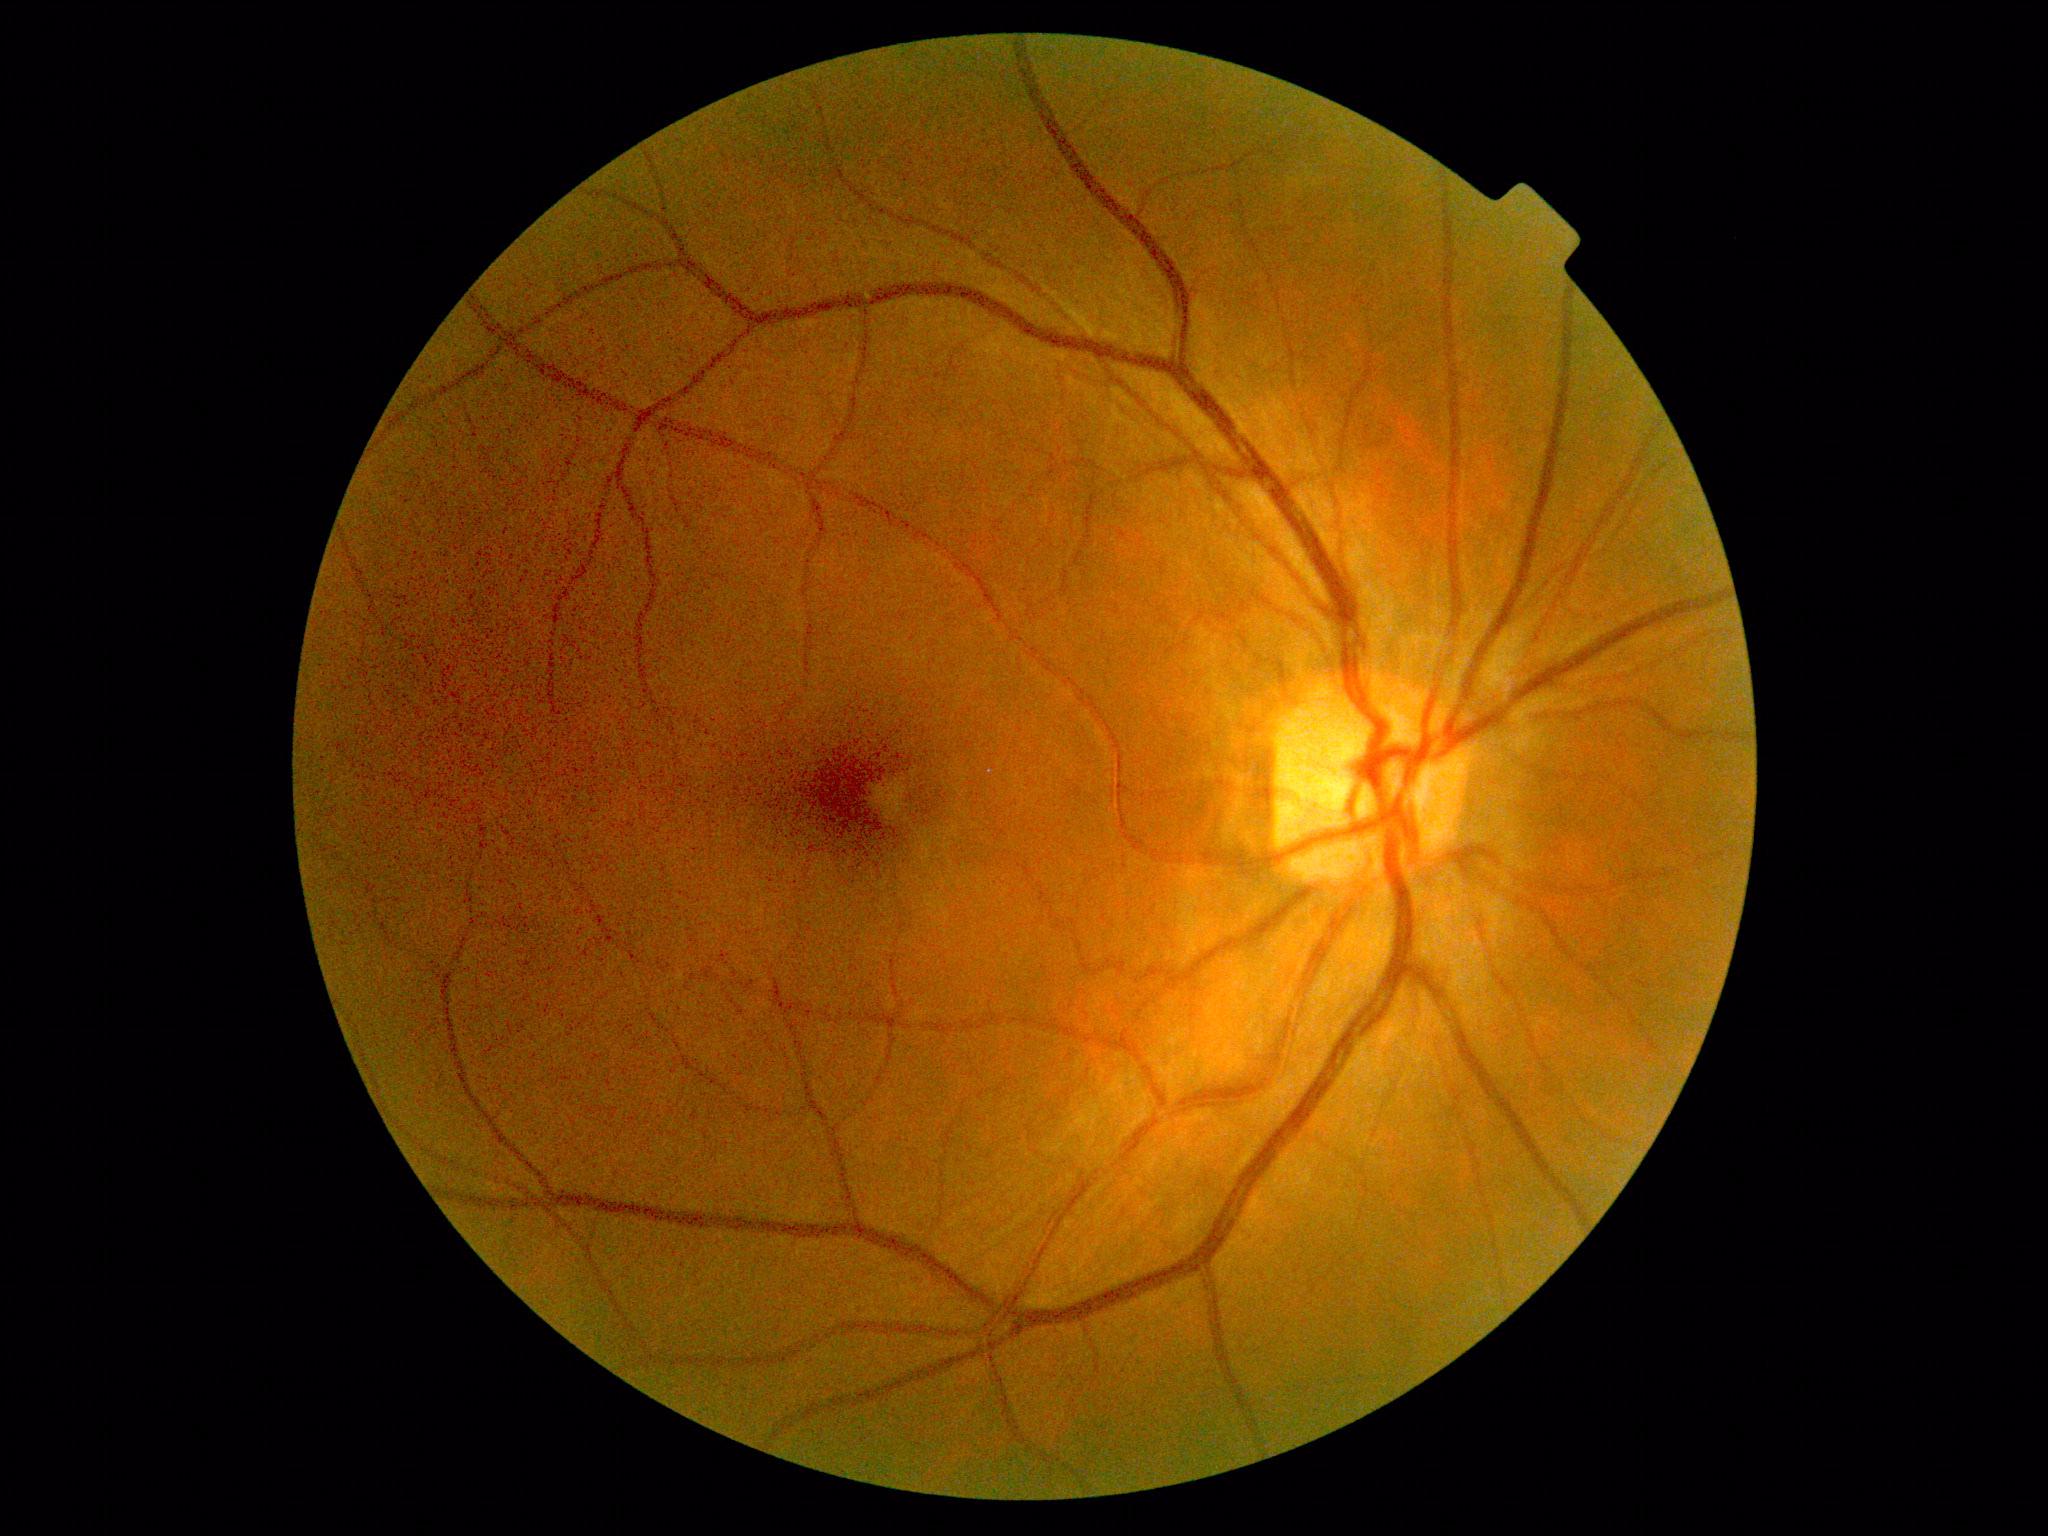

Retinopathy: no apparent diabetic retinopathy (grade 0). No diabetic retinal disease findings.